45° FOV, 2352x1568px:
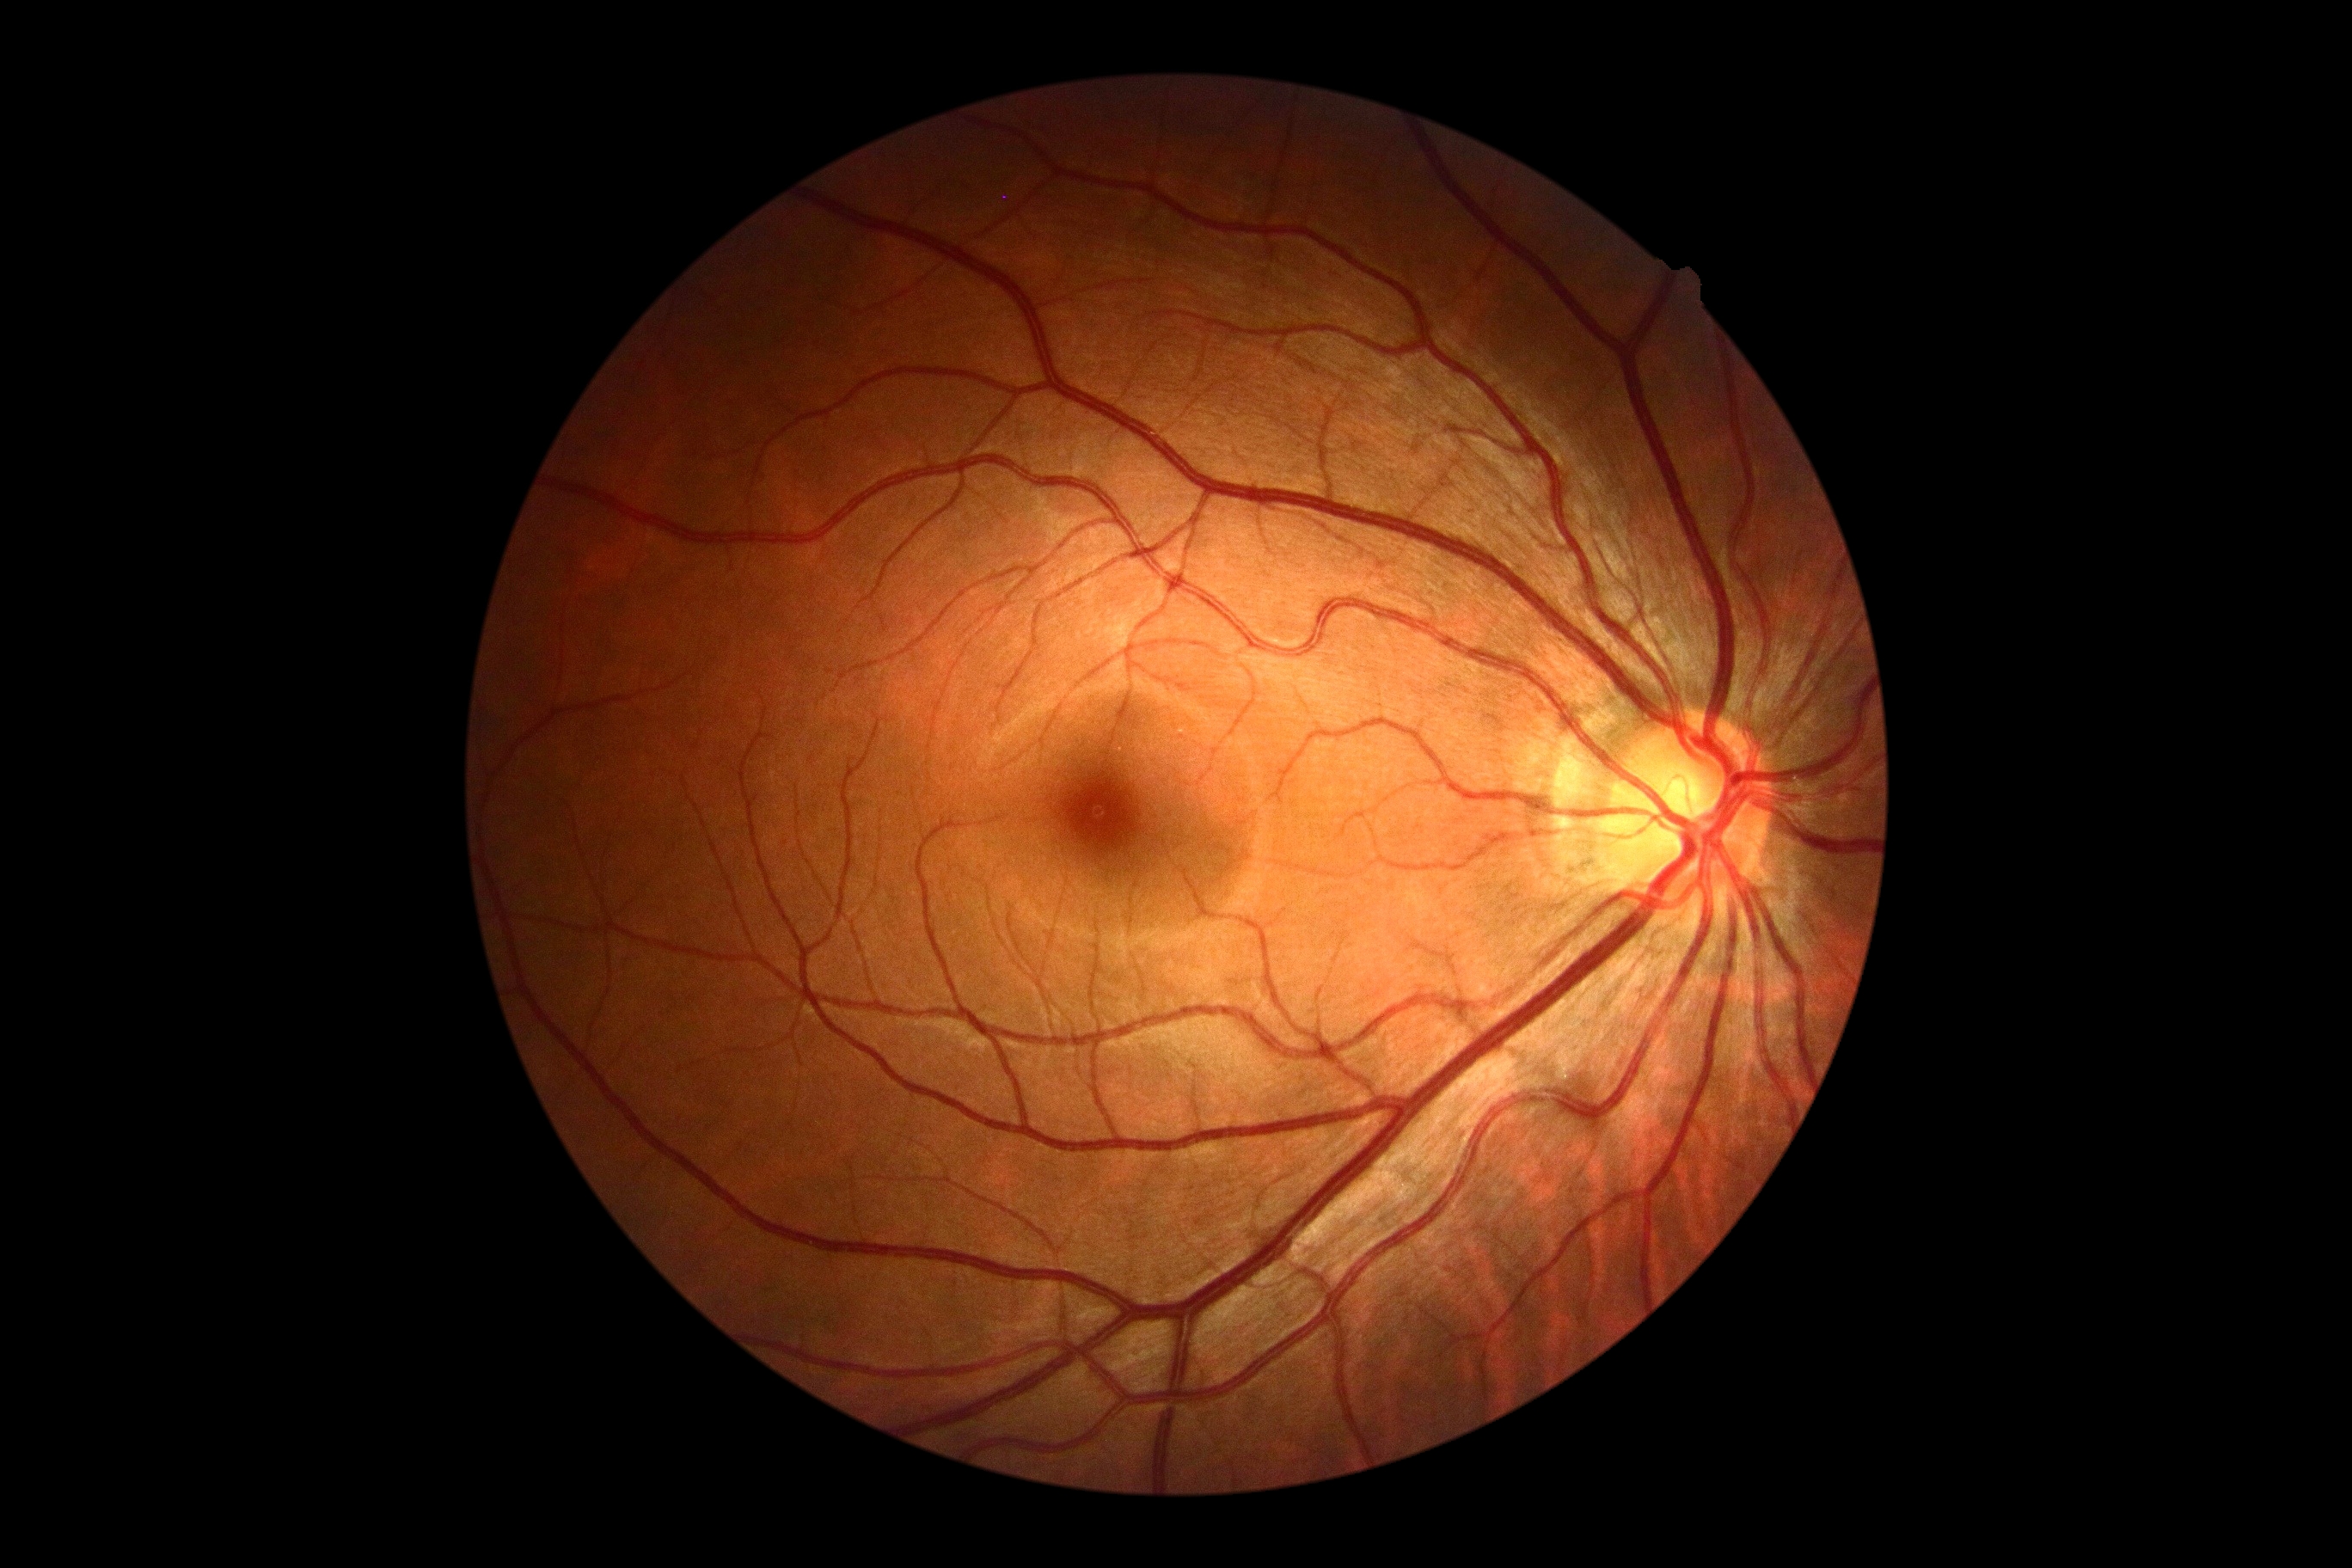 Diabetic retinopathy: 0. No signs of diabetic retinopathy.